Retinal fundus photograph · 2352x1568px: 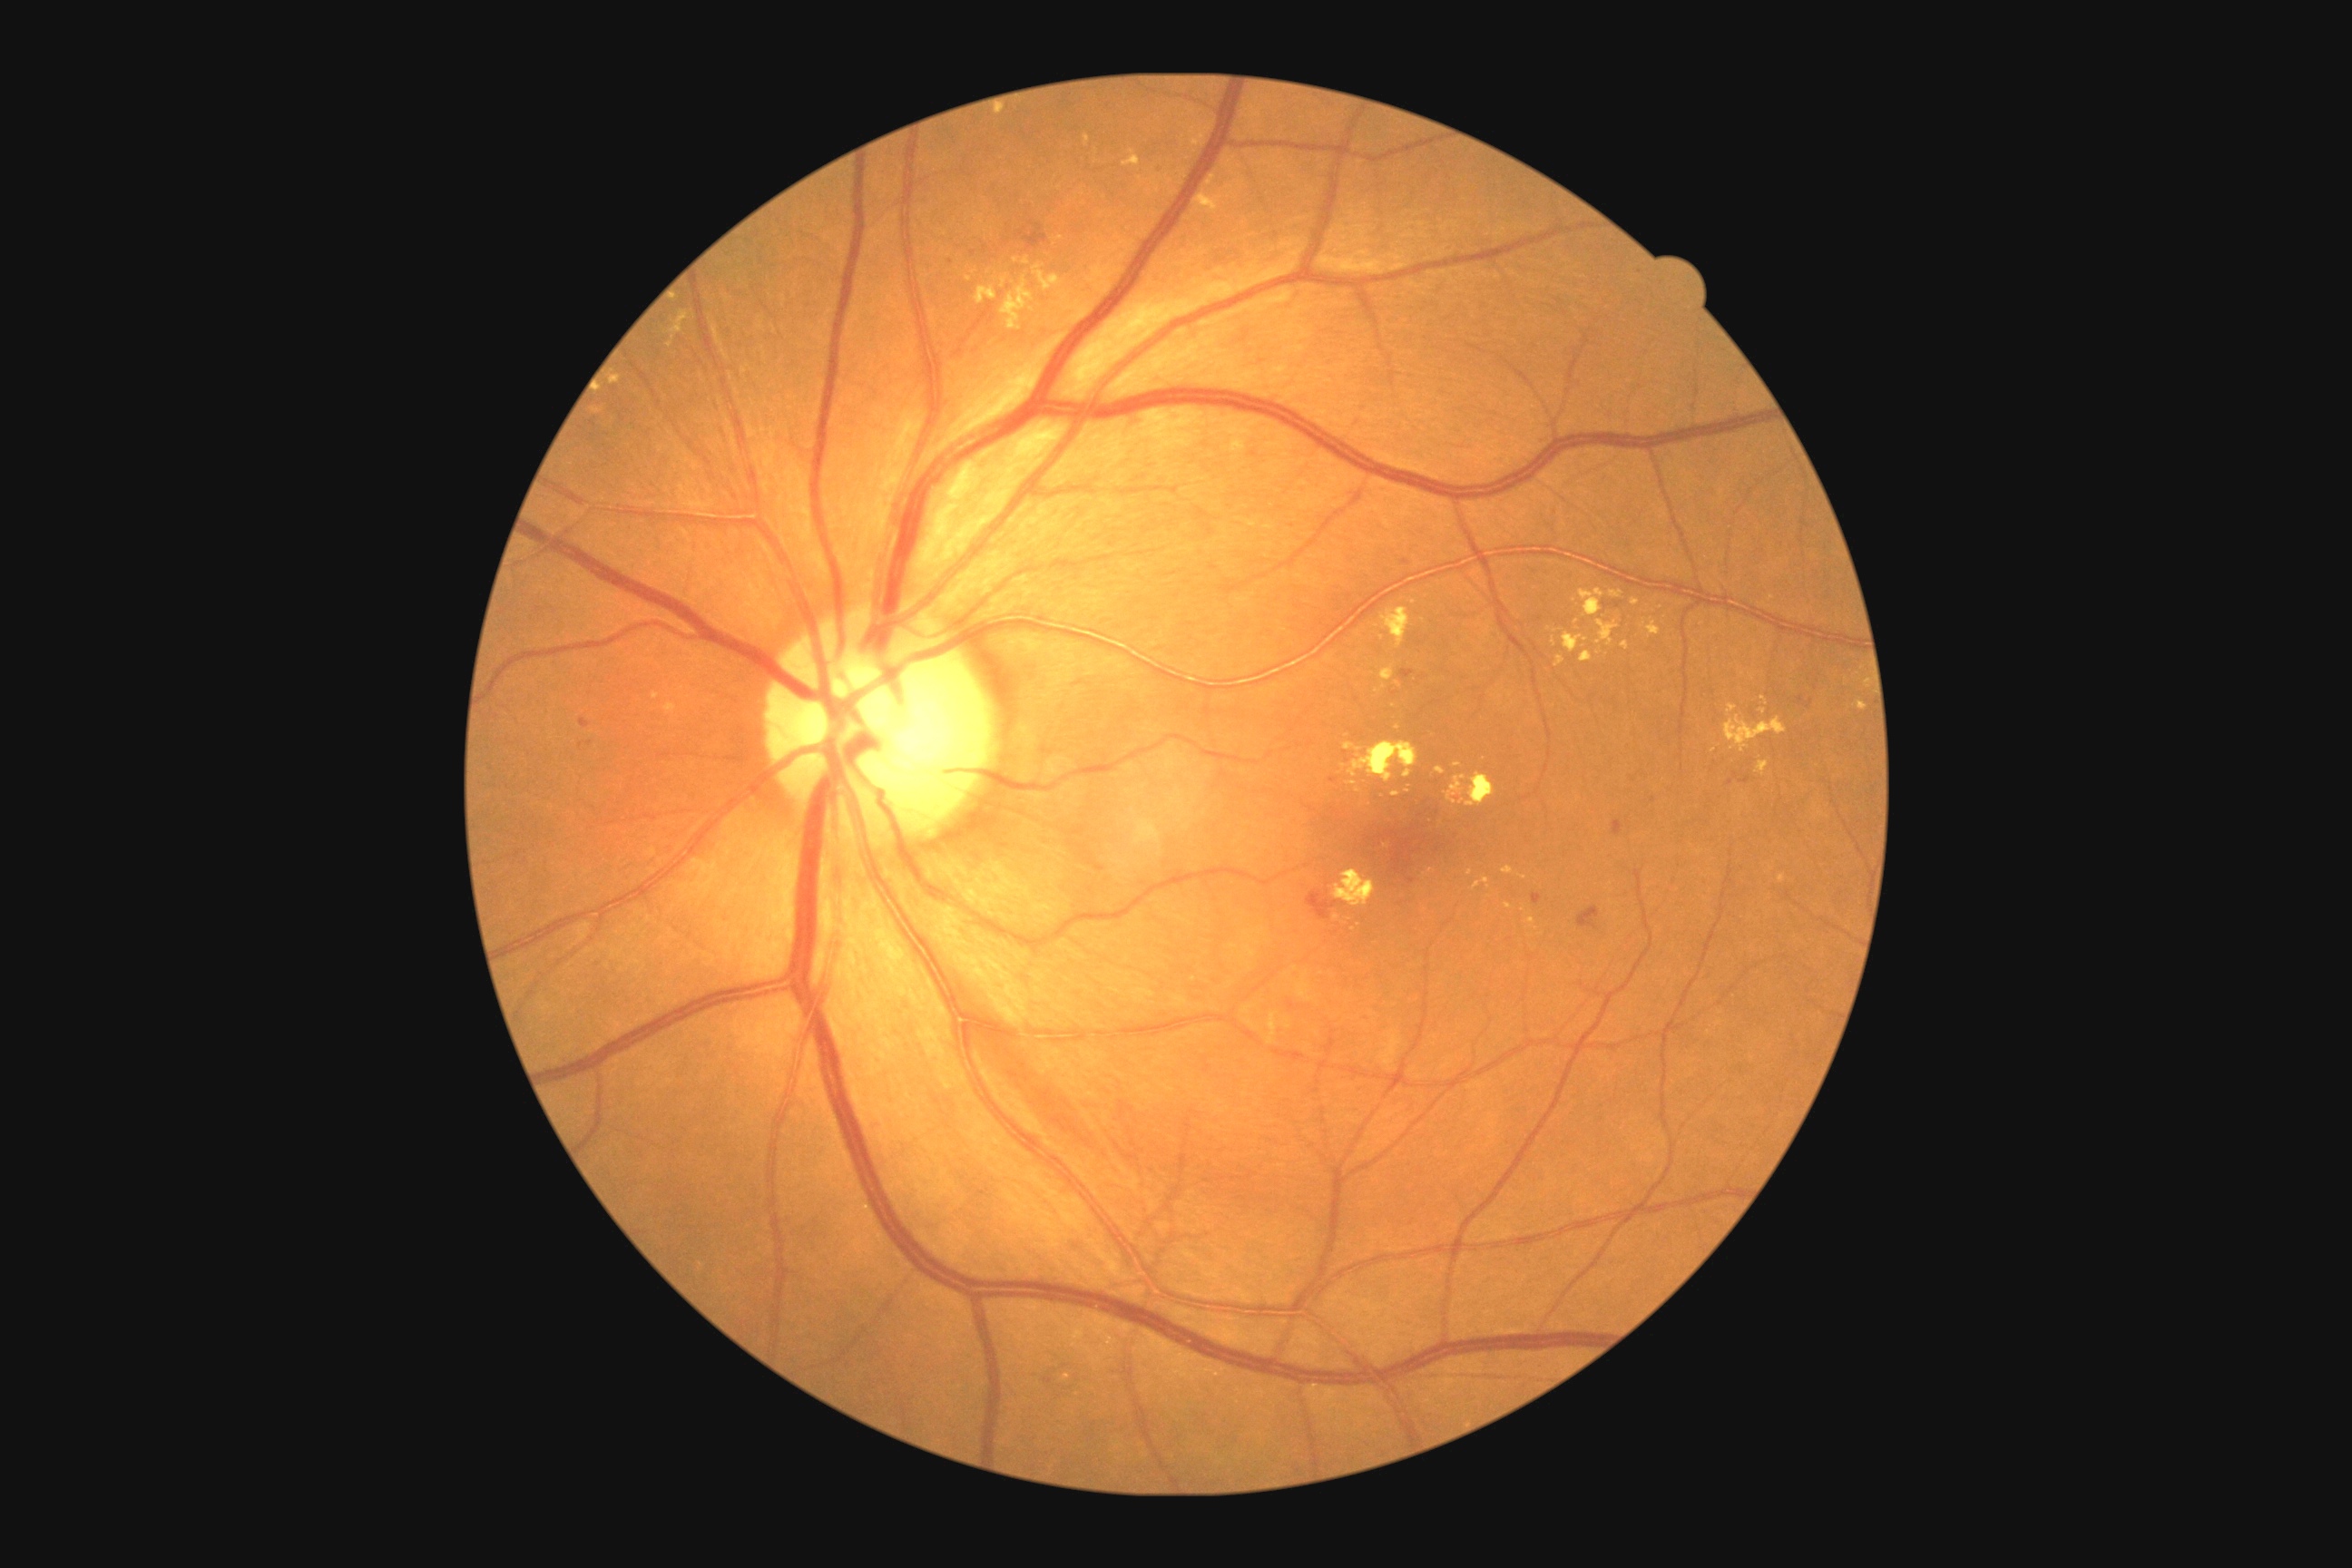
partial: true
dr_grade: 2
lesions:
  ex:
    - bbox=[975, 286, 997, 304]
    - bbox=[1446, 776, 1467, 805]
    - bbox=[1554, 656, 1565, 669]
    - bbox=[1436, 767, 1446, 776]
    - bbox=[611, 377, 622, 384]
    - bbox=[1333, 870, 1377, 908]
    - bbox=[995, 110, 1004, 115]
    - bbox=[1023, 257, 1030, 266]
    - bbox=[1505, 903, 1513, 908]
    - bbox=[667, 311, 689, 348]
    - bbox=[663, 703, 678, 716]
    - bbox=[1375, 685, 1386, 694]
  ex_small_approx:
    - [x=1067, y=1377]
    - [x=1336, y=918]
    - [x=1060, y=238]
    - [x=1358, y=792]
    - [x=1407, y=792]
    - [x=1714, y=750]